No pharmacologic dilation; acquired with a NIDEK AFC-230: 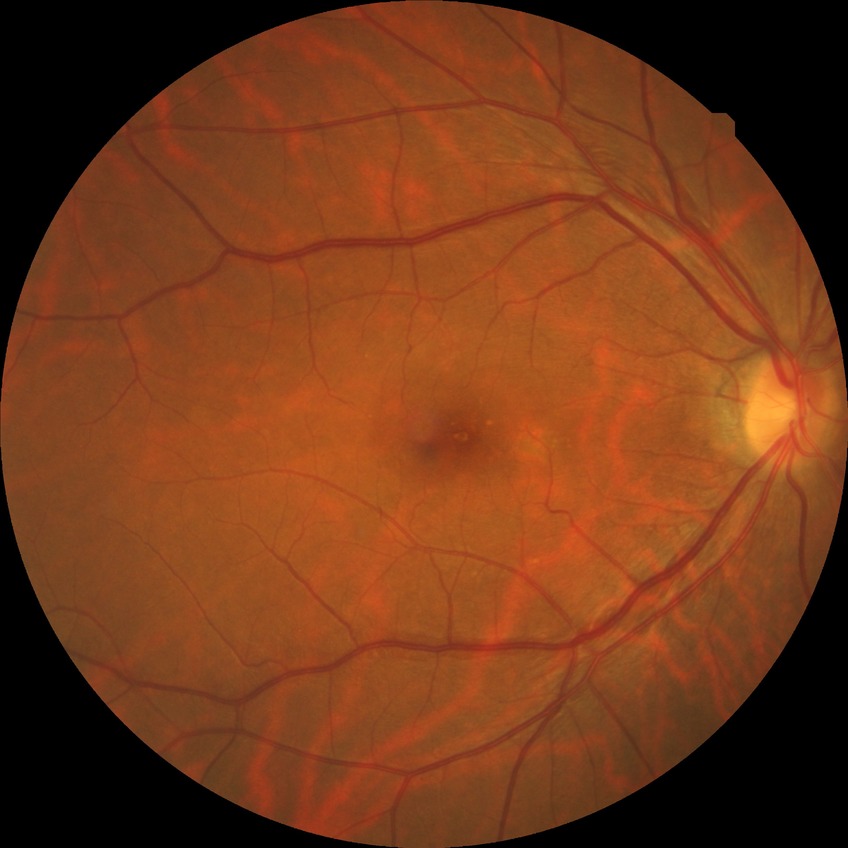 Diabetic retinopathy stage is no diabetic retinopathy.